Image size 1659x2212 — 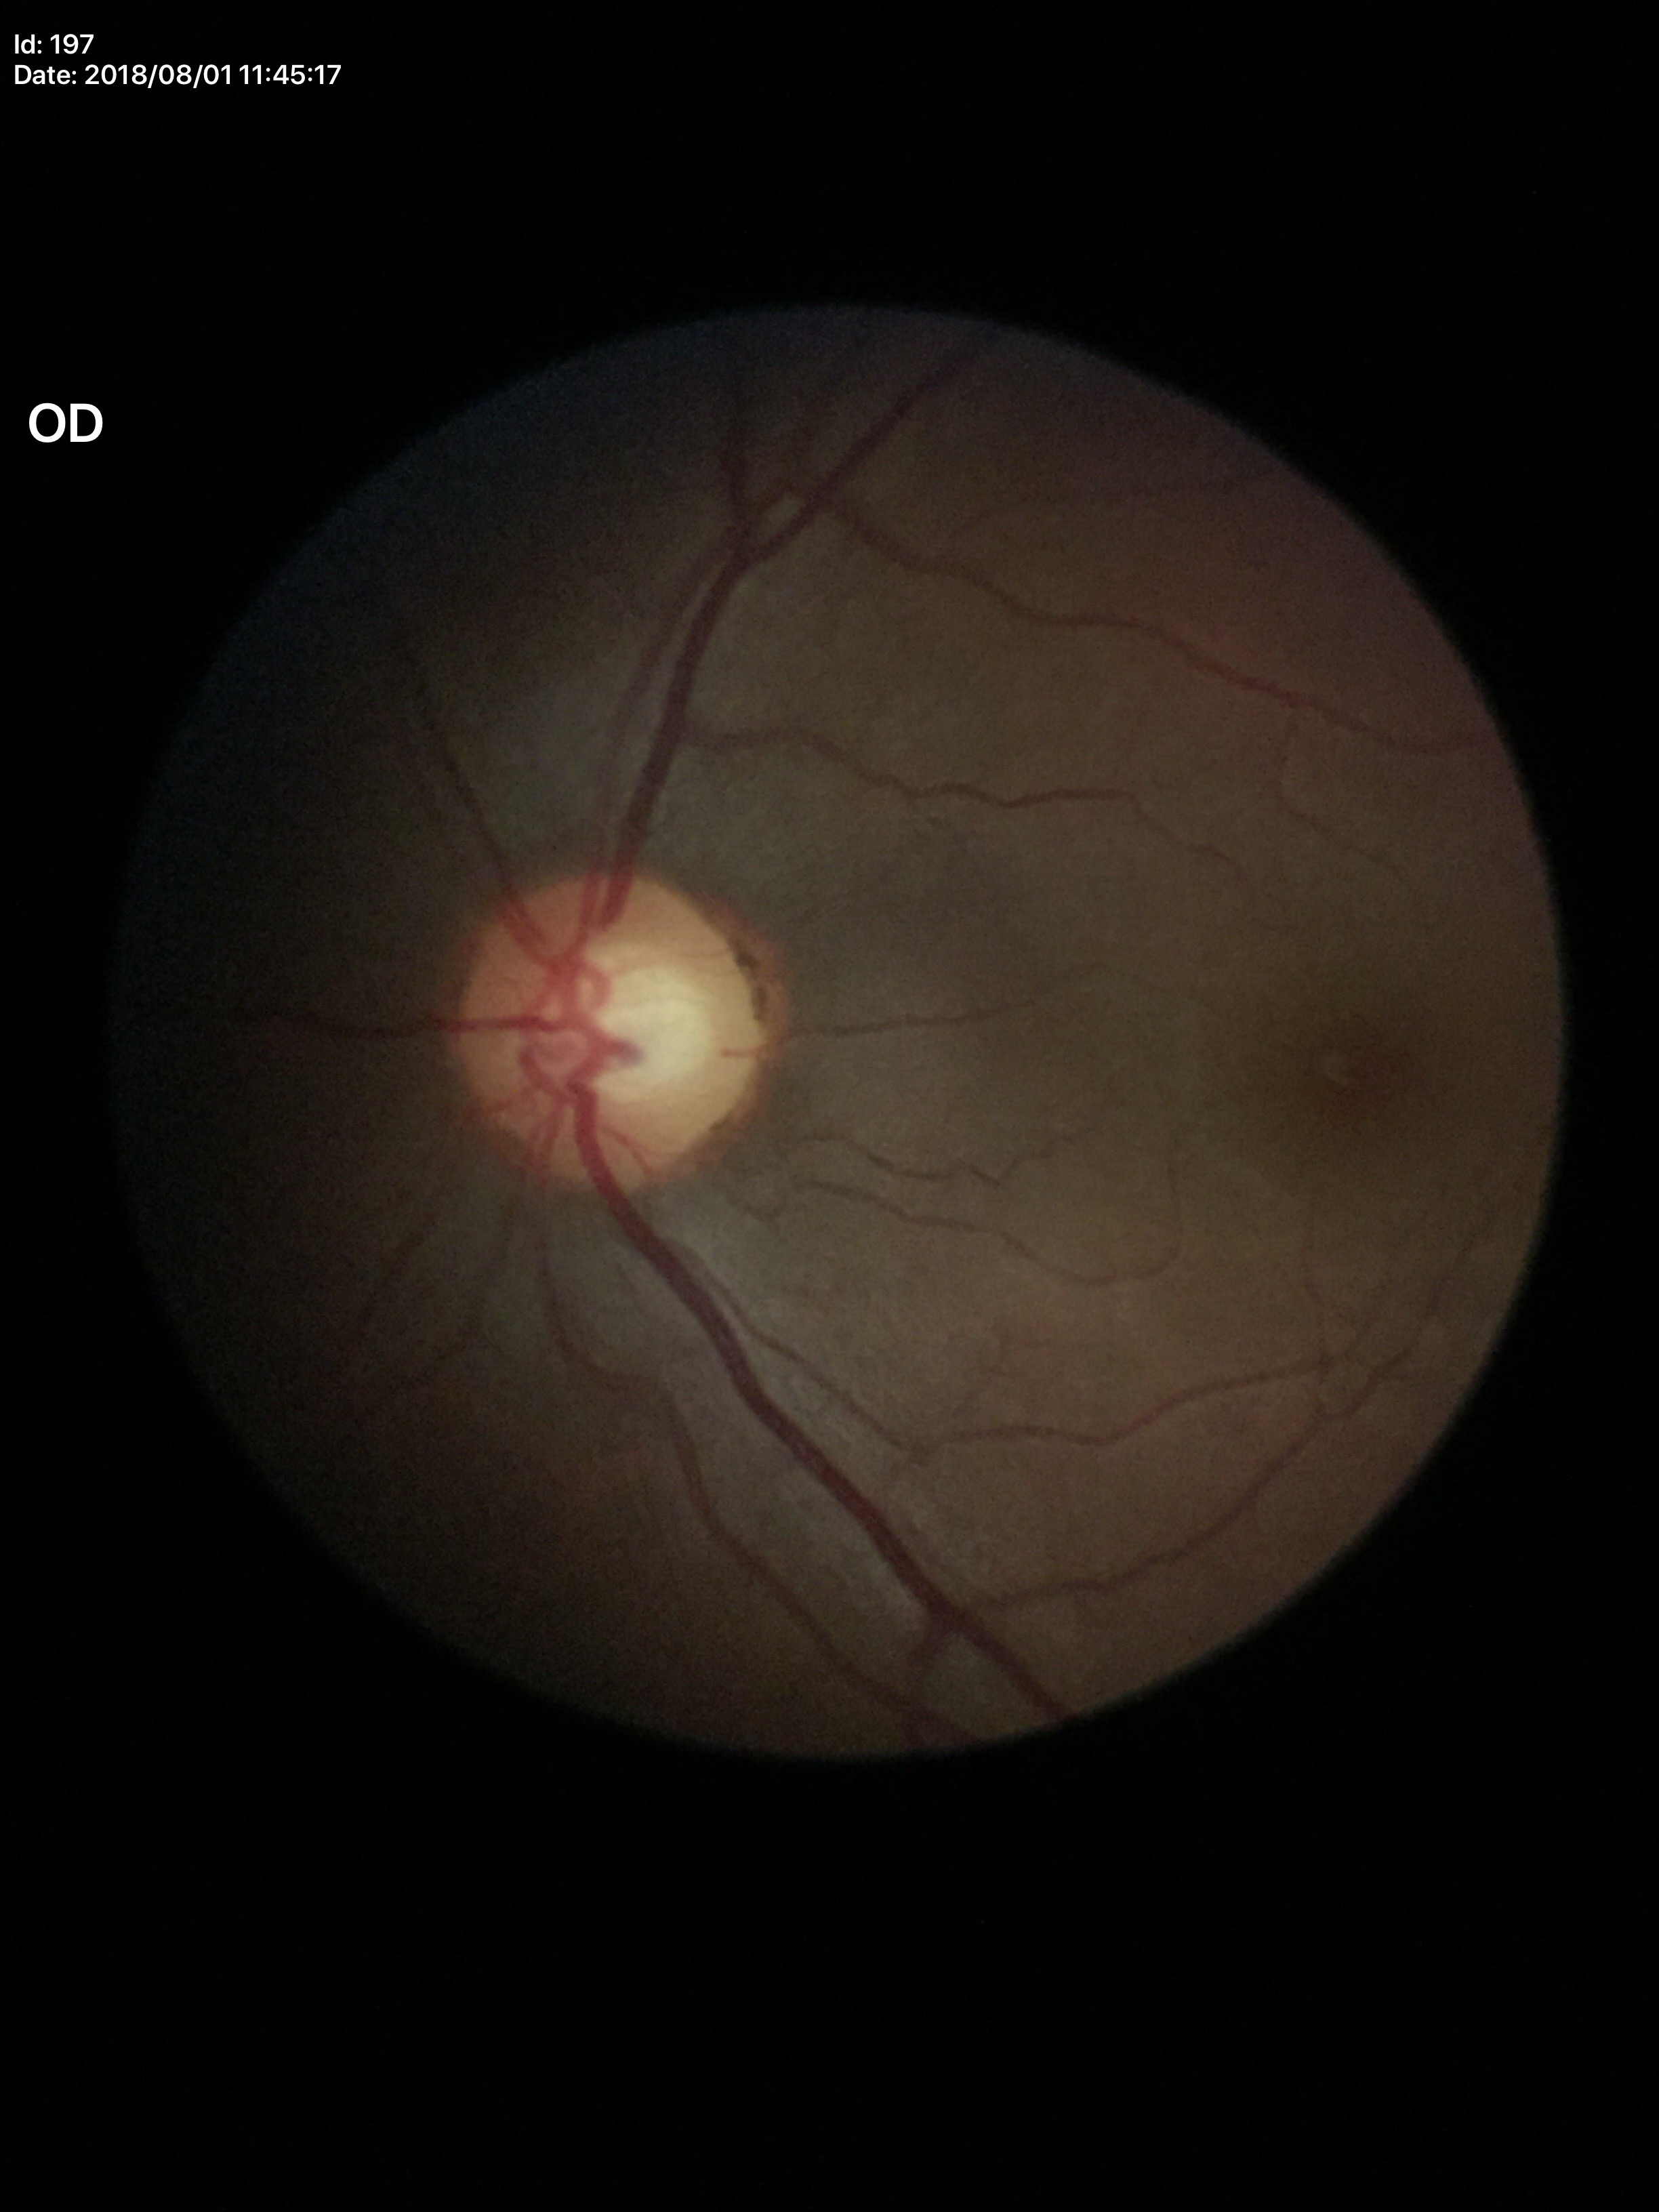 {
  "vcdr": "0.57",
  "glaucoma_decision": "no suspicious findings"
}